Fundus photo:
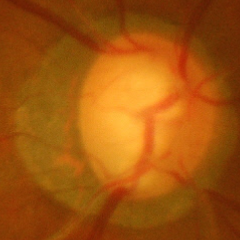
Demonstrates severe glaucomatous damage.